Captured on a Remidio Fundus on Phone (FOP) camera; color fundus photograph; 1659x2212: 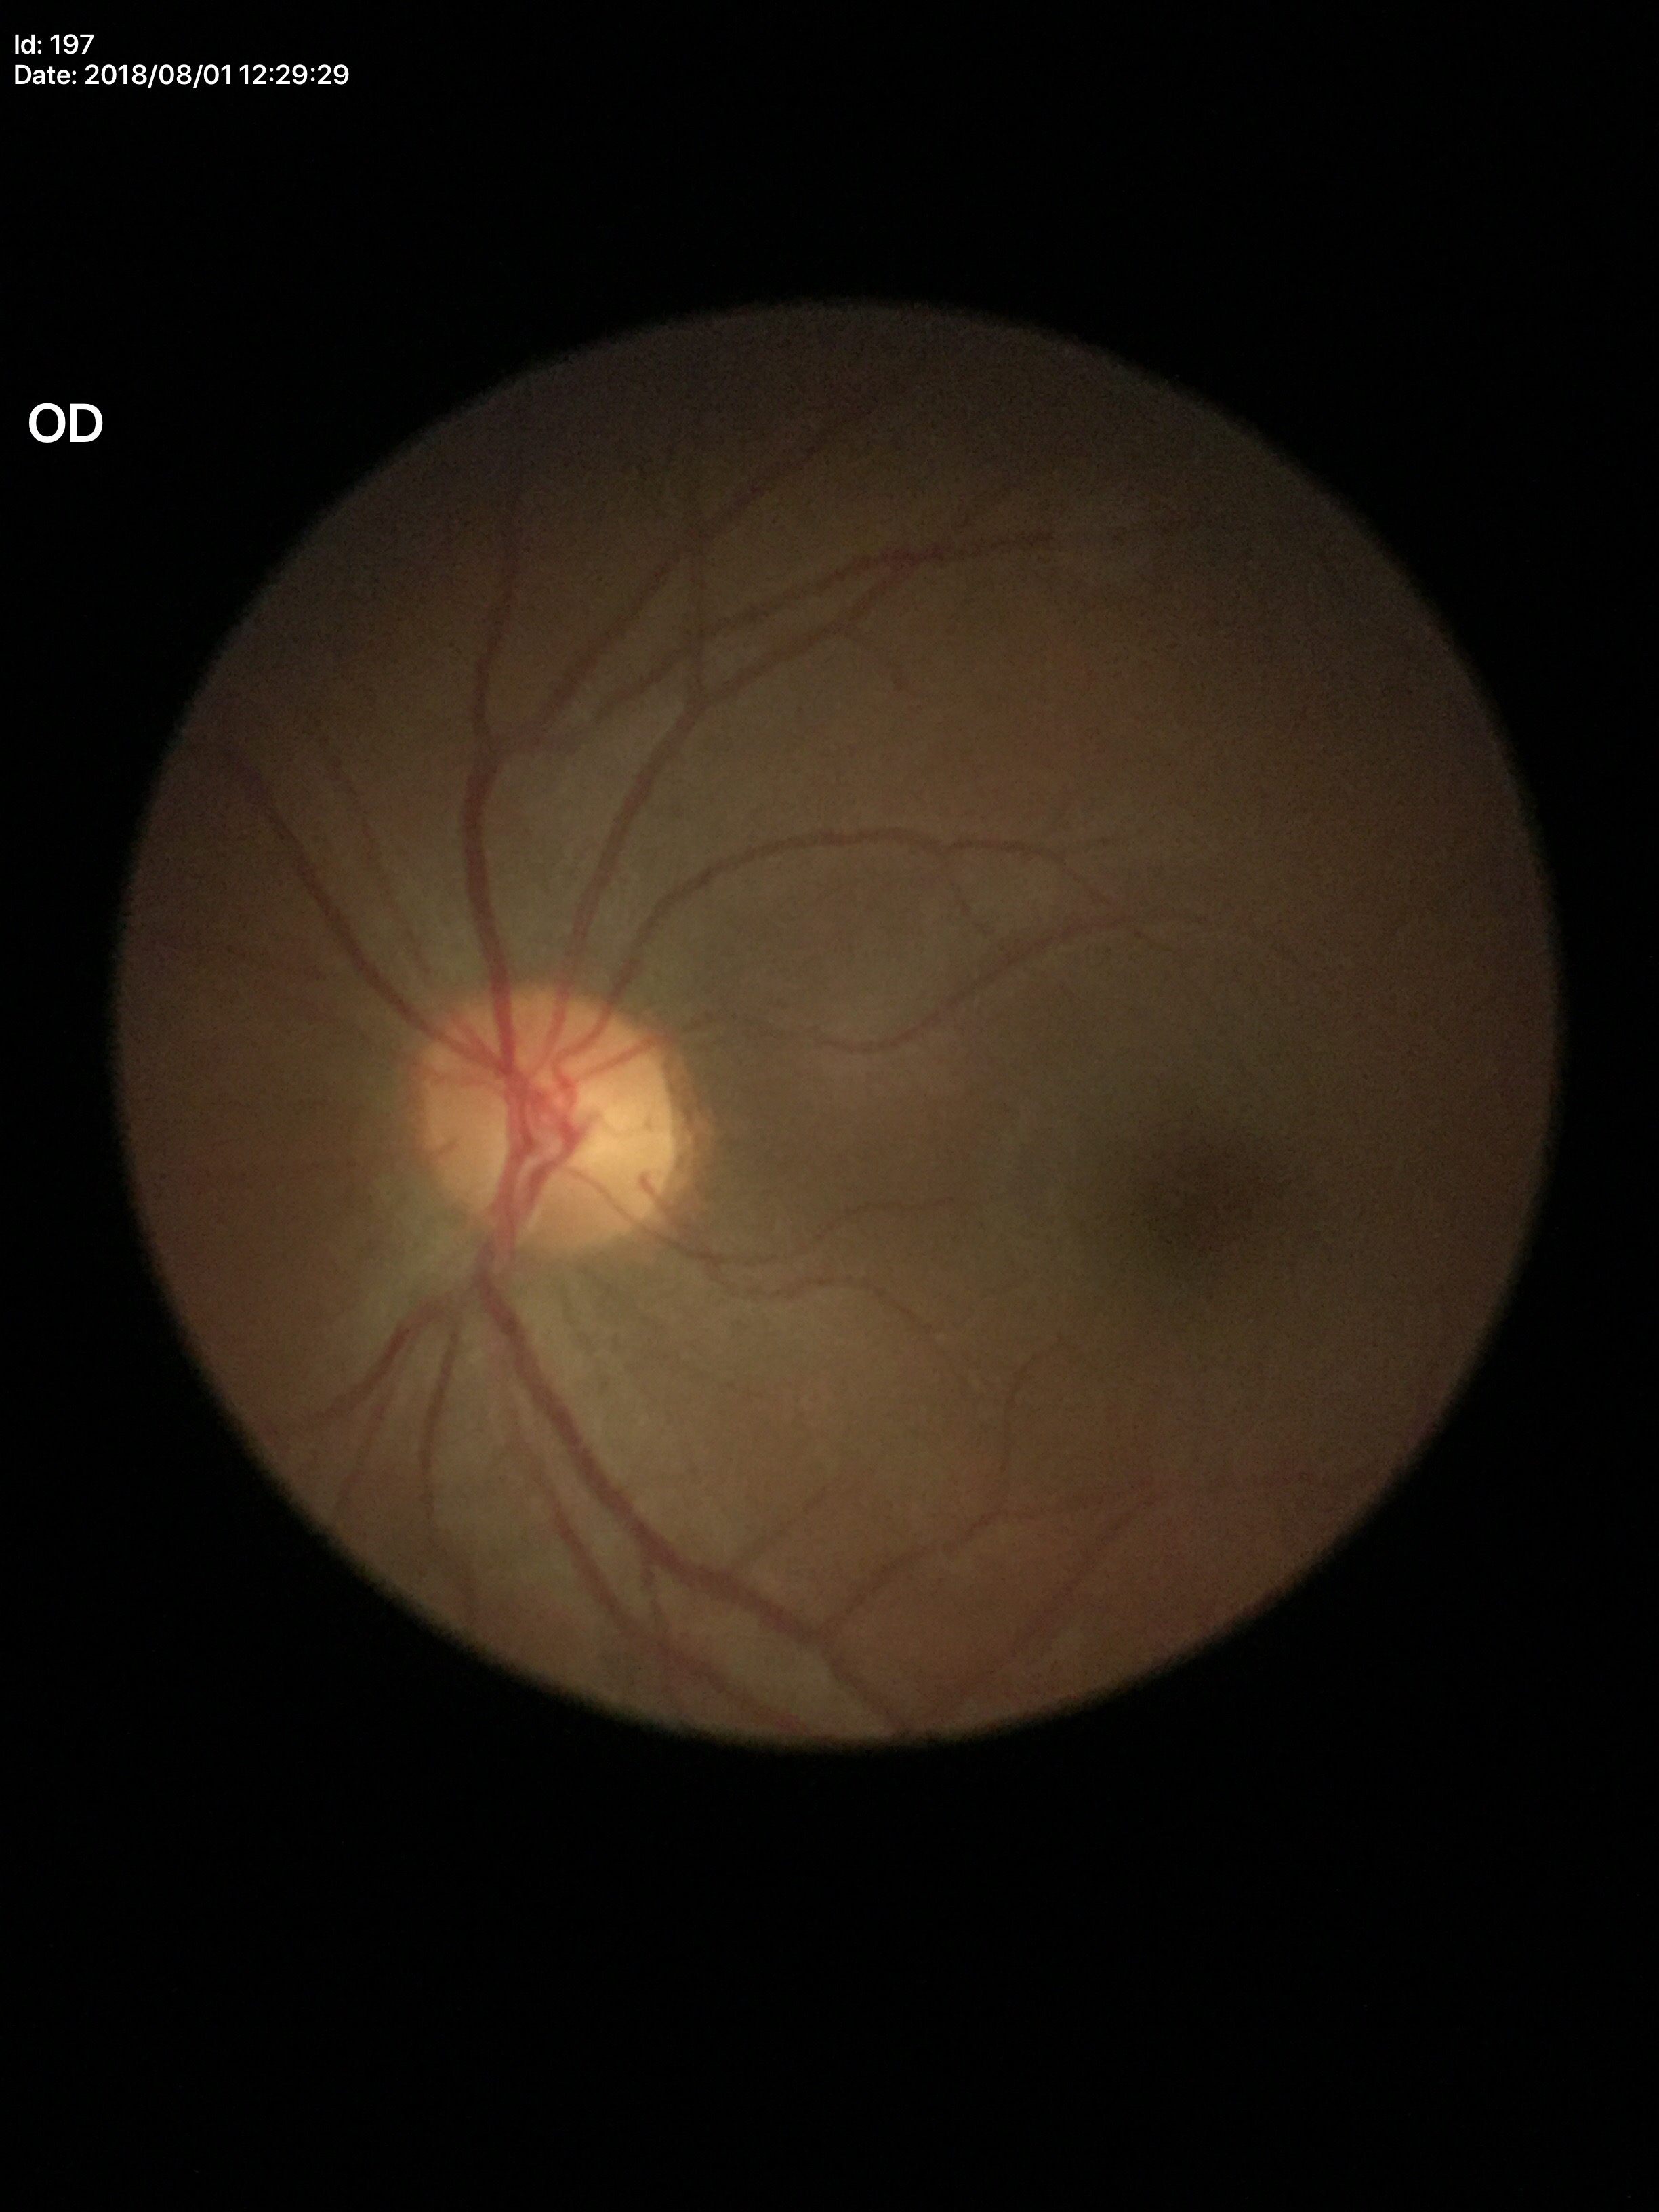

Vertical C/D ratio of 0.52.
No glaucomatous findings (all 5 graders called normal).